848 x 848 pixels — 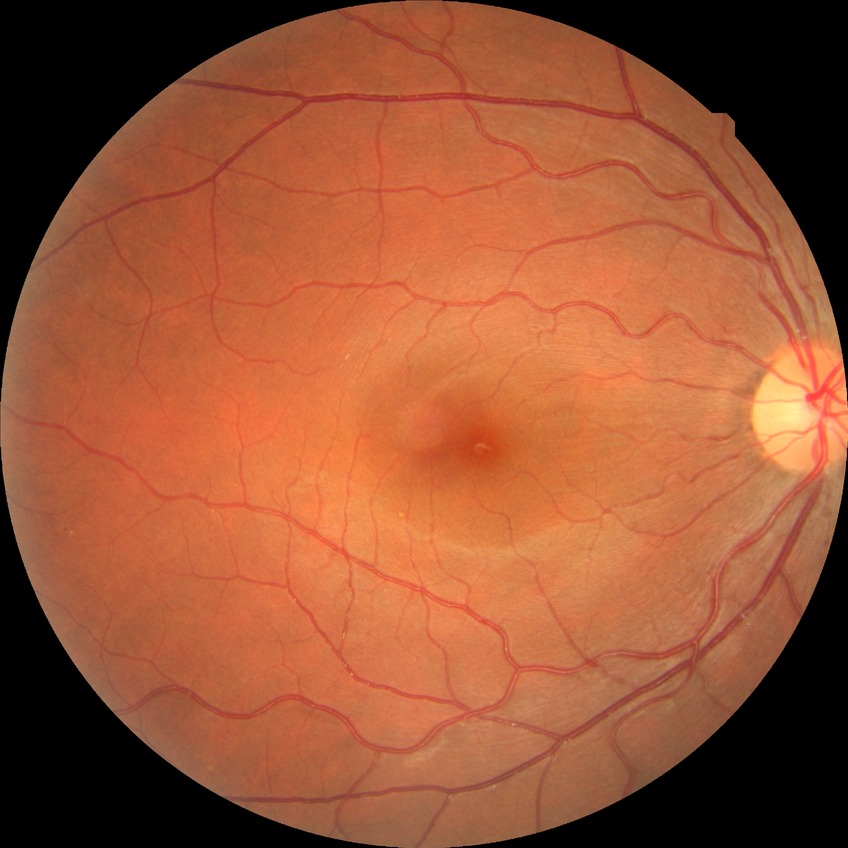

retinopathy stage: no diabetic retinopathy.